640x480px · captured with the Clarity RetCam 3 (130° field of view) · wide-field fundus photograph from neonatal ROP screening: 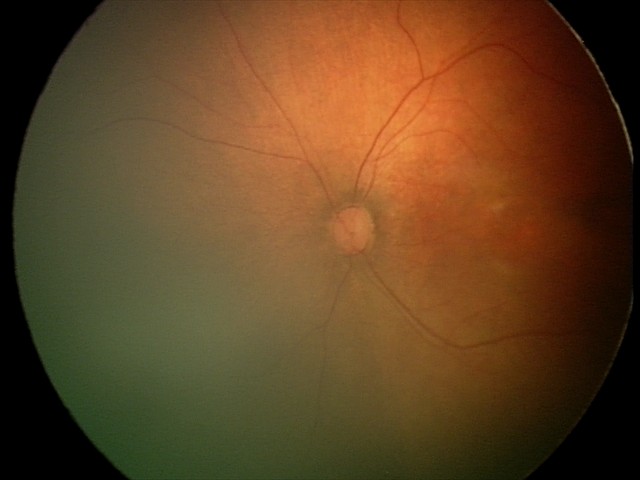

Impression: normal fundus examination.